Wide-field fundus image from infant ROP screening; camera: Natus RetCam Envision (130° FOV).
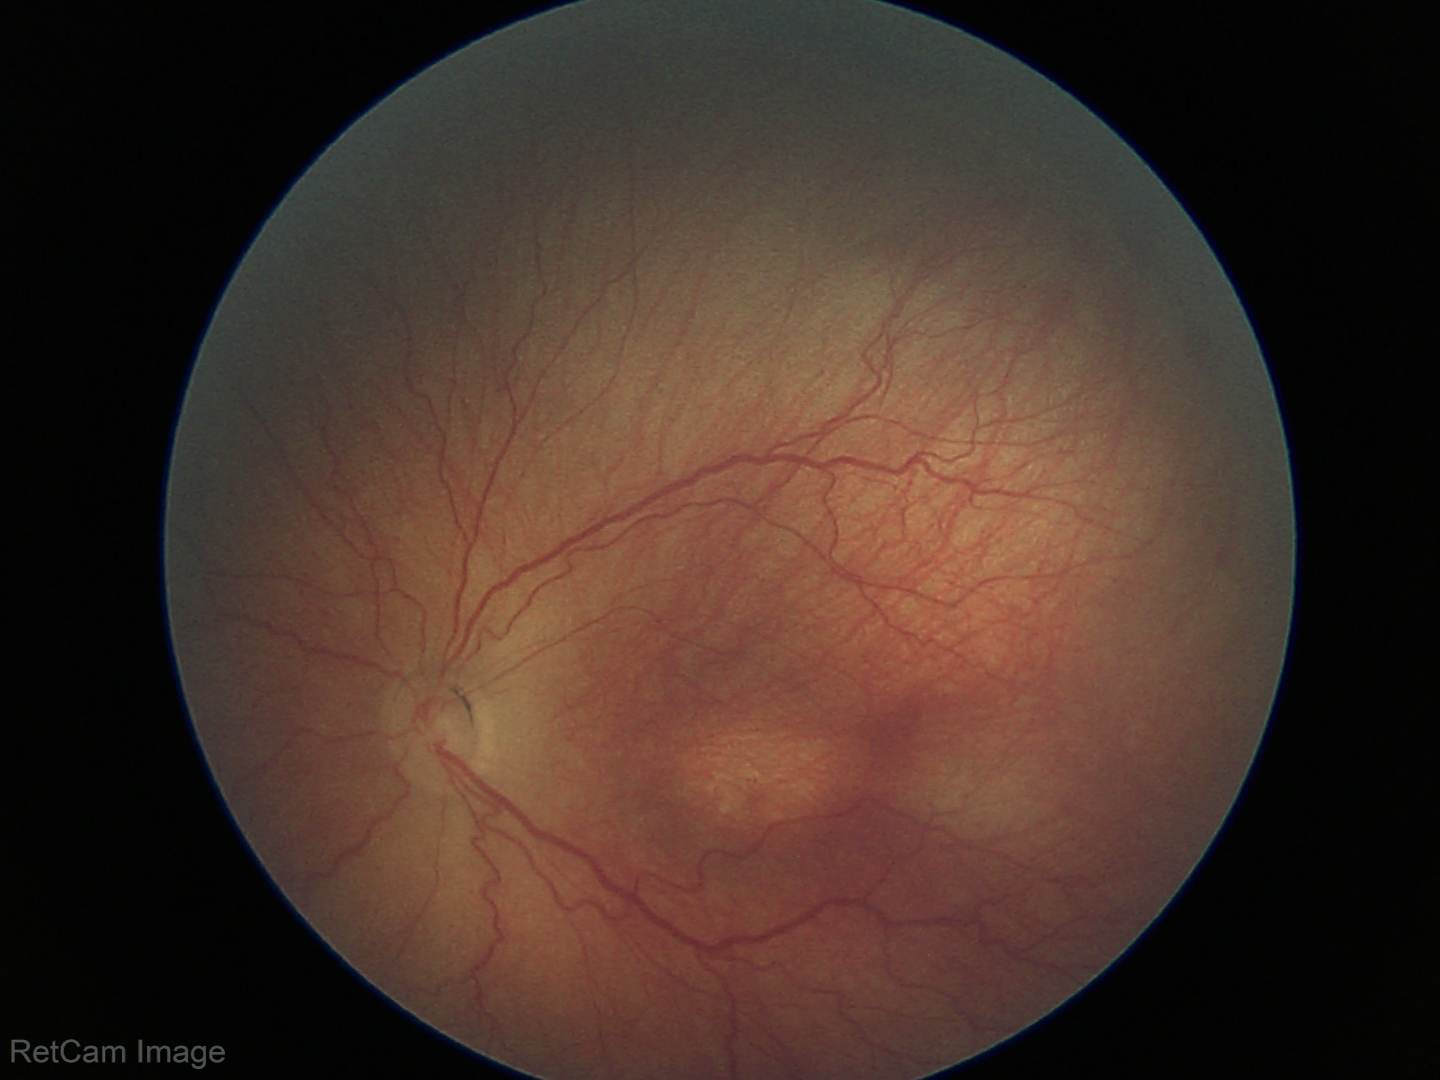 Screening examination consistent with ROP stage 3.